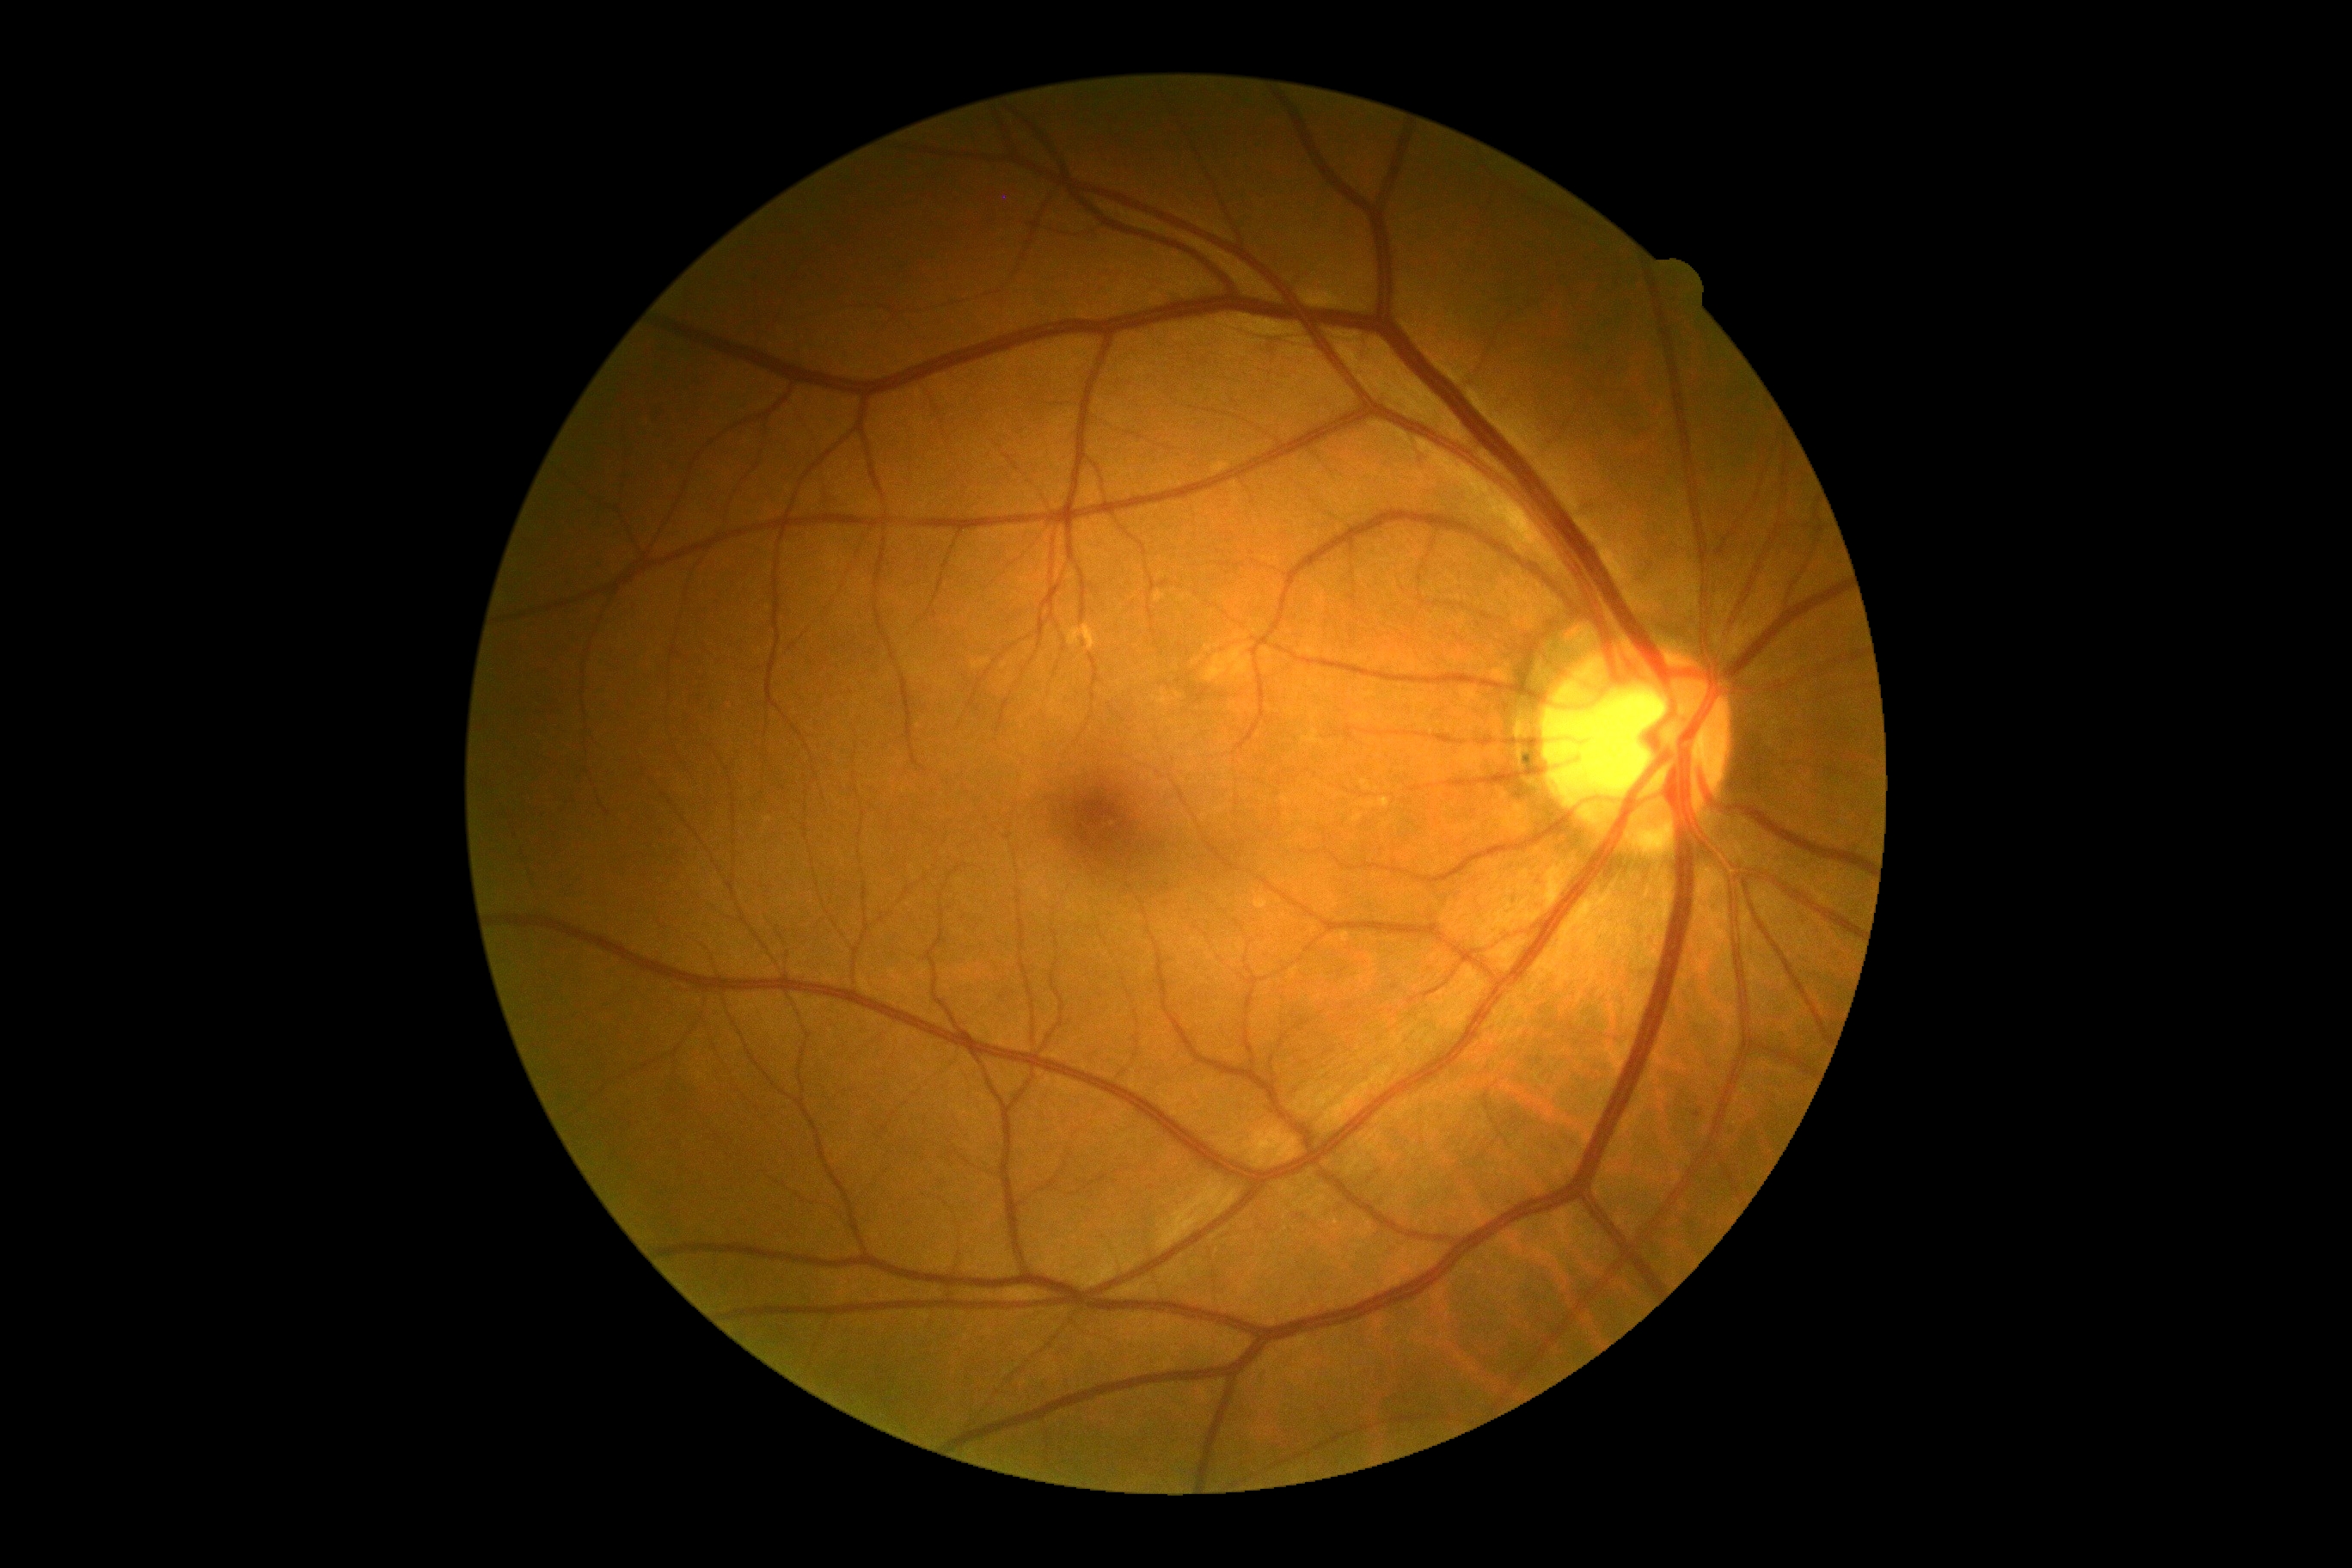
Annotations:
* DR impression — negative for DR
* diabetic retinopathy — grade 0